Davis DR grading; posterior pole color fundus photograph — 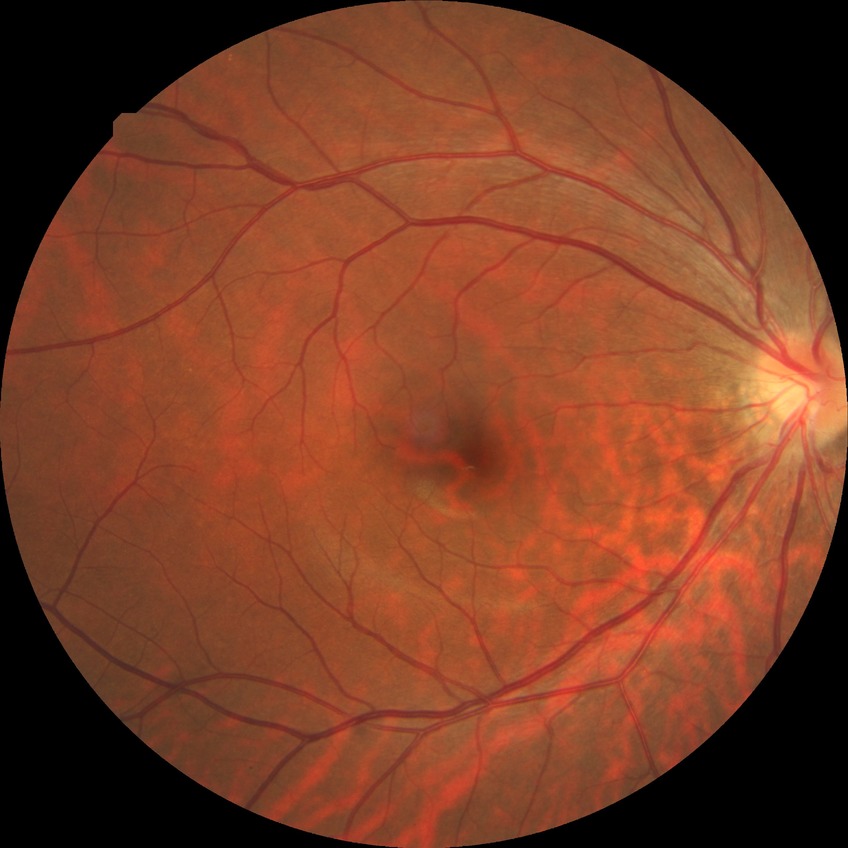 Diabetic retinopathy (DR) is no diabetic retinopathy (NDR).